2352x1568px. 45° field of view. Fundus photo — 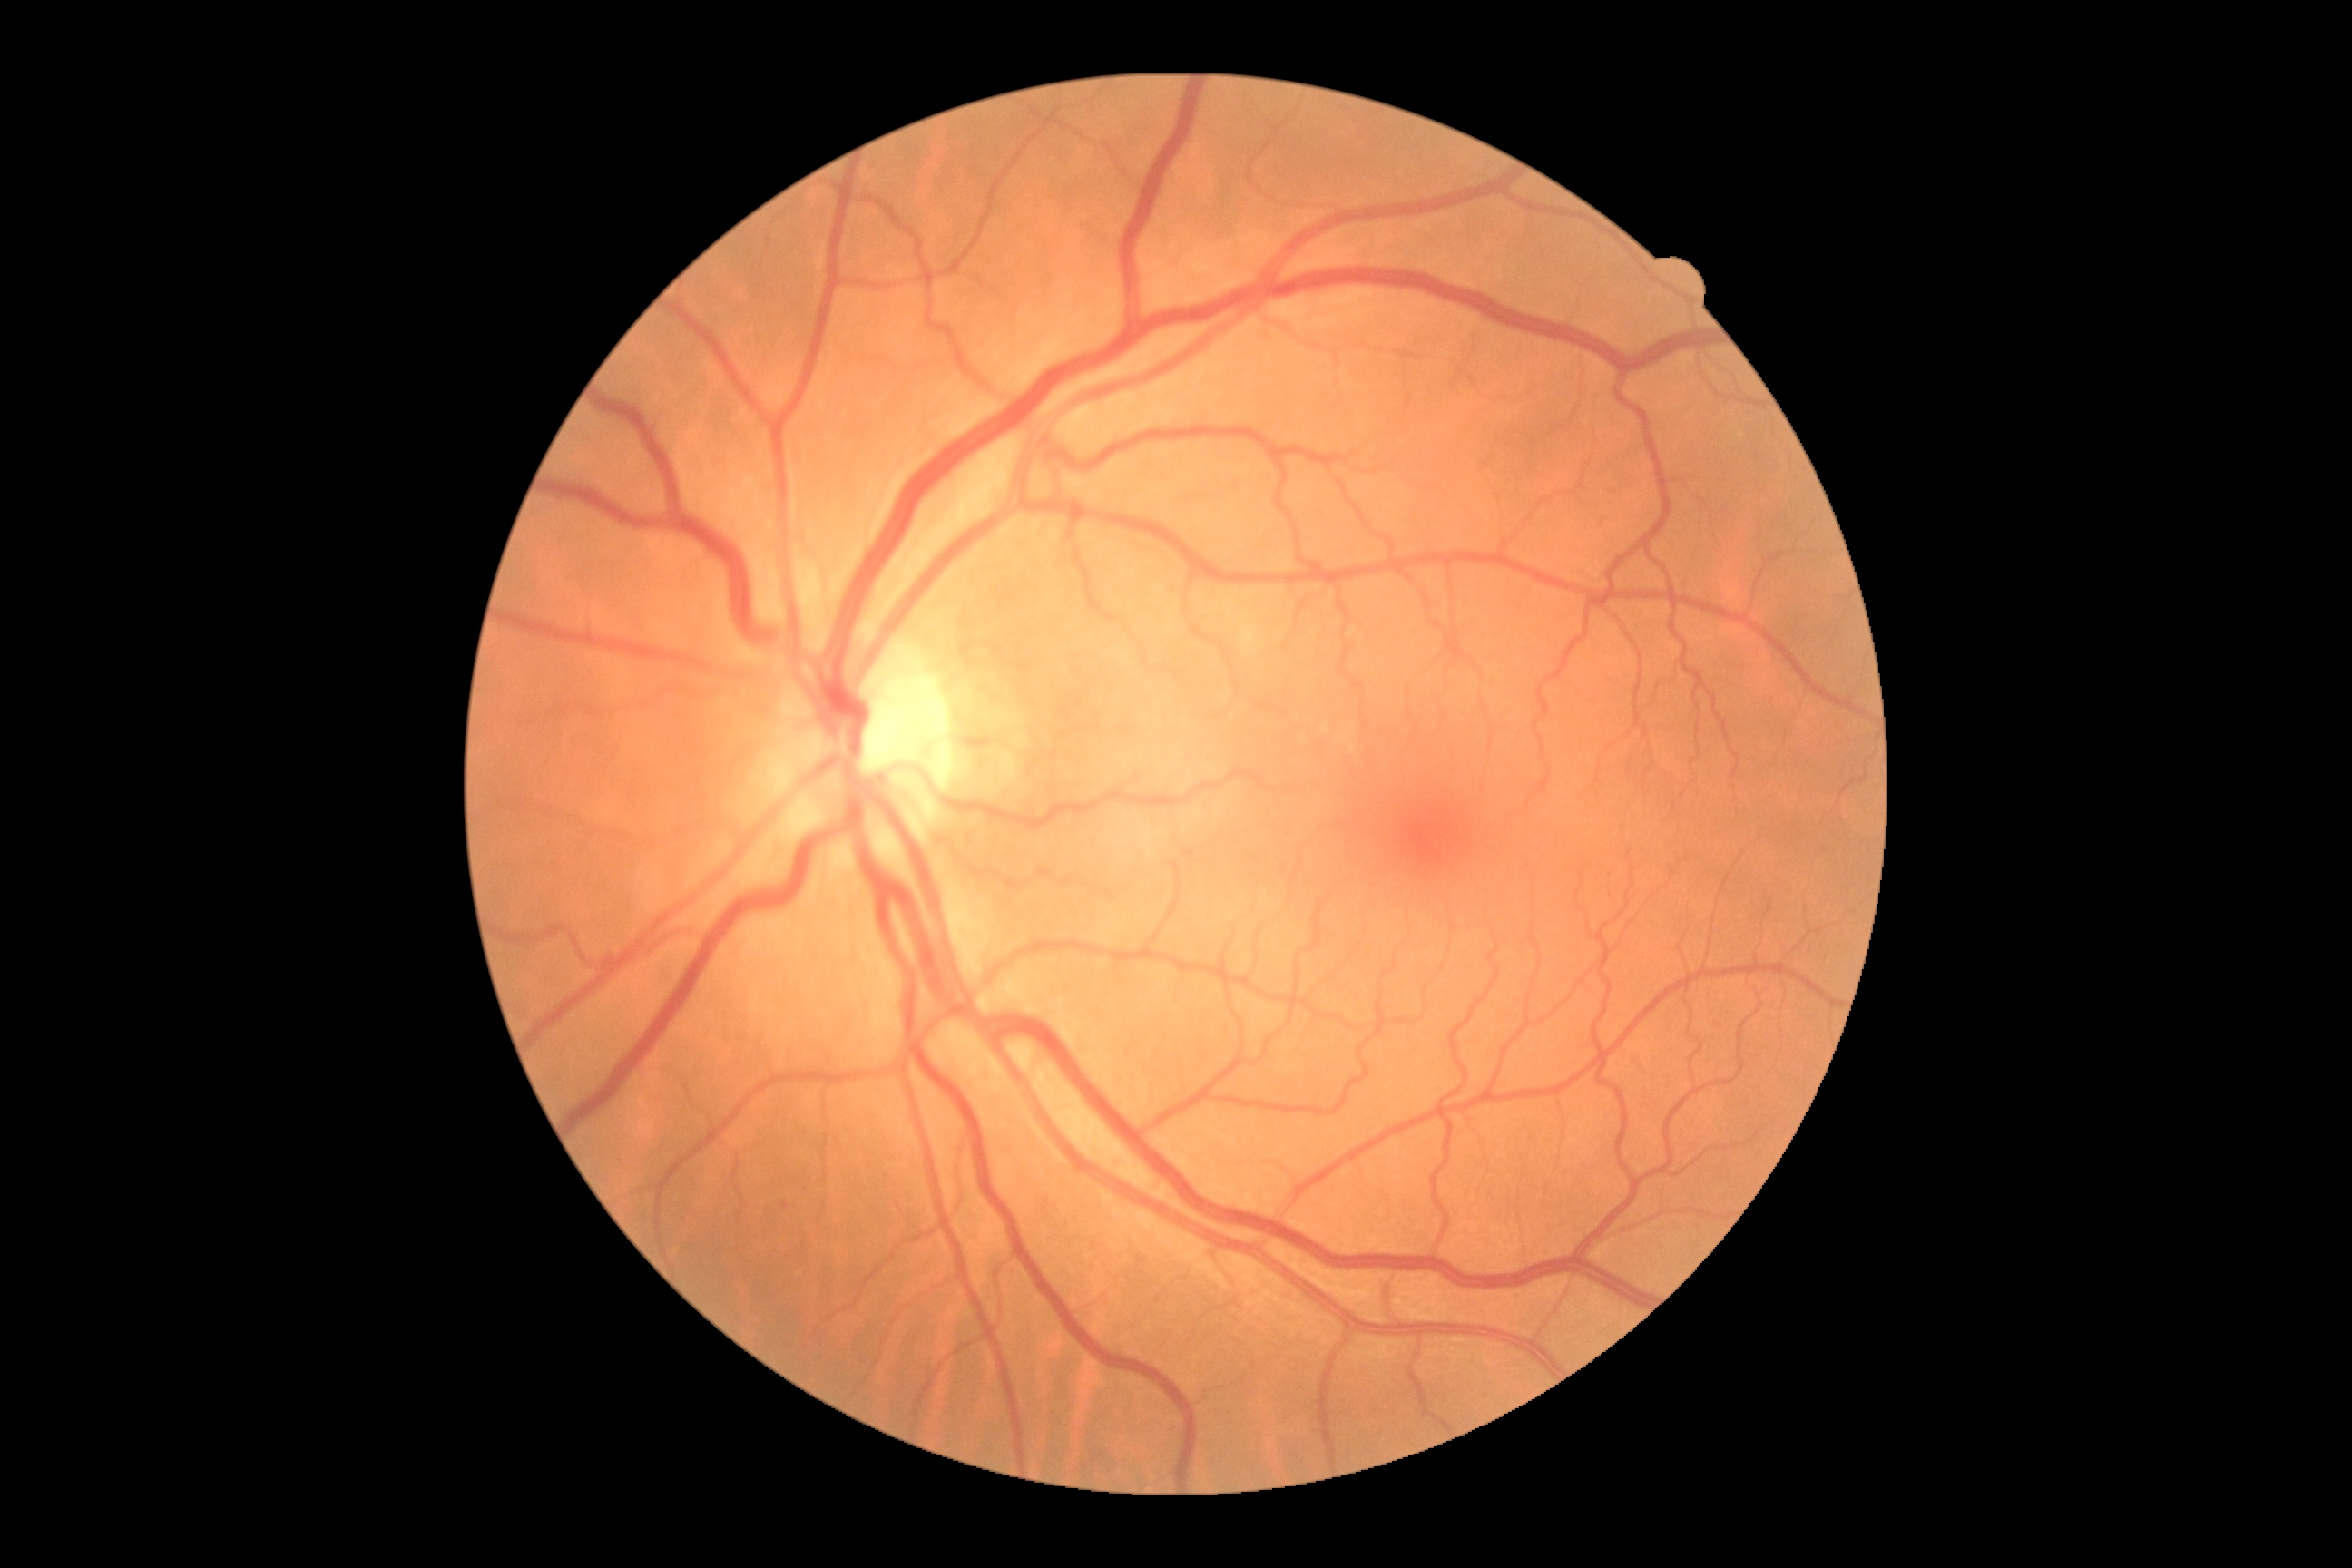
retinopathy=grade 0 (no apparent retinopathy).